Camera: NIDEK AFC-230; 848 x 848 pixels
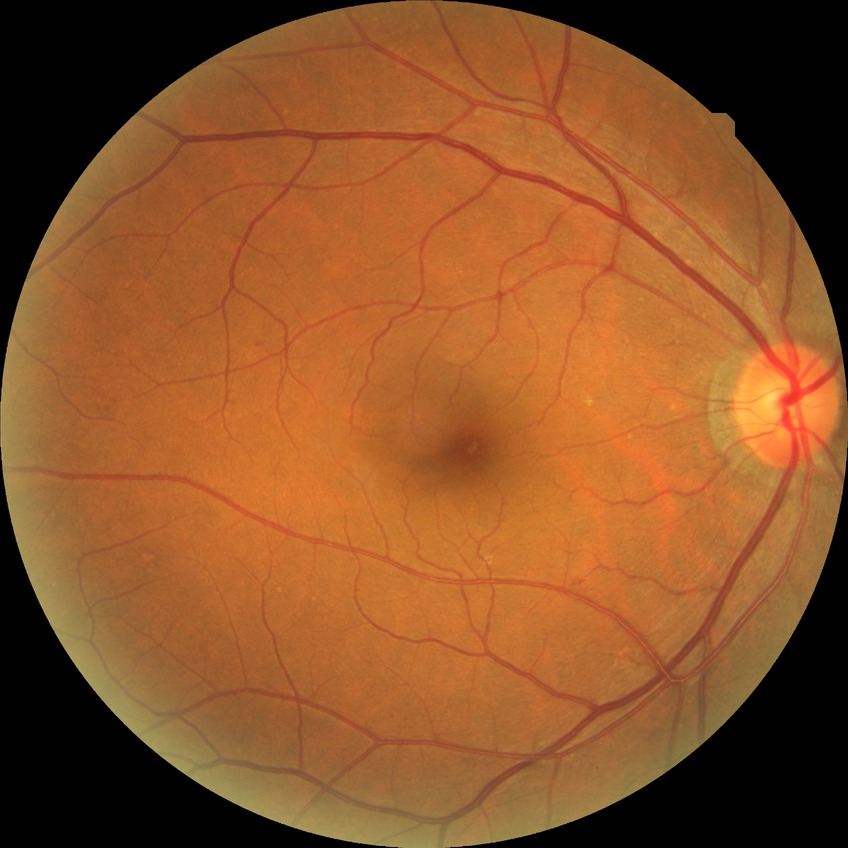
Diabetic retinopathy (DR): no diabetic retinopathy (NDR).